Wide-field contact fundus photograph of an infant. 1240 by 1240 pixels — 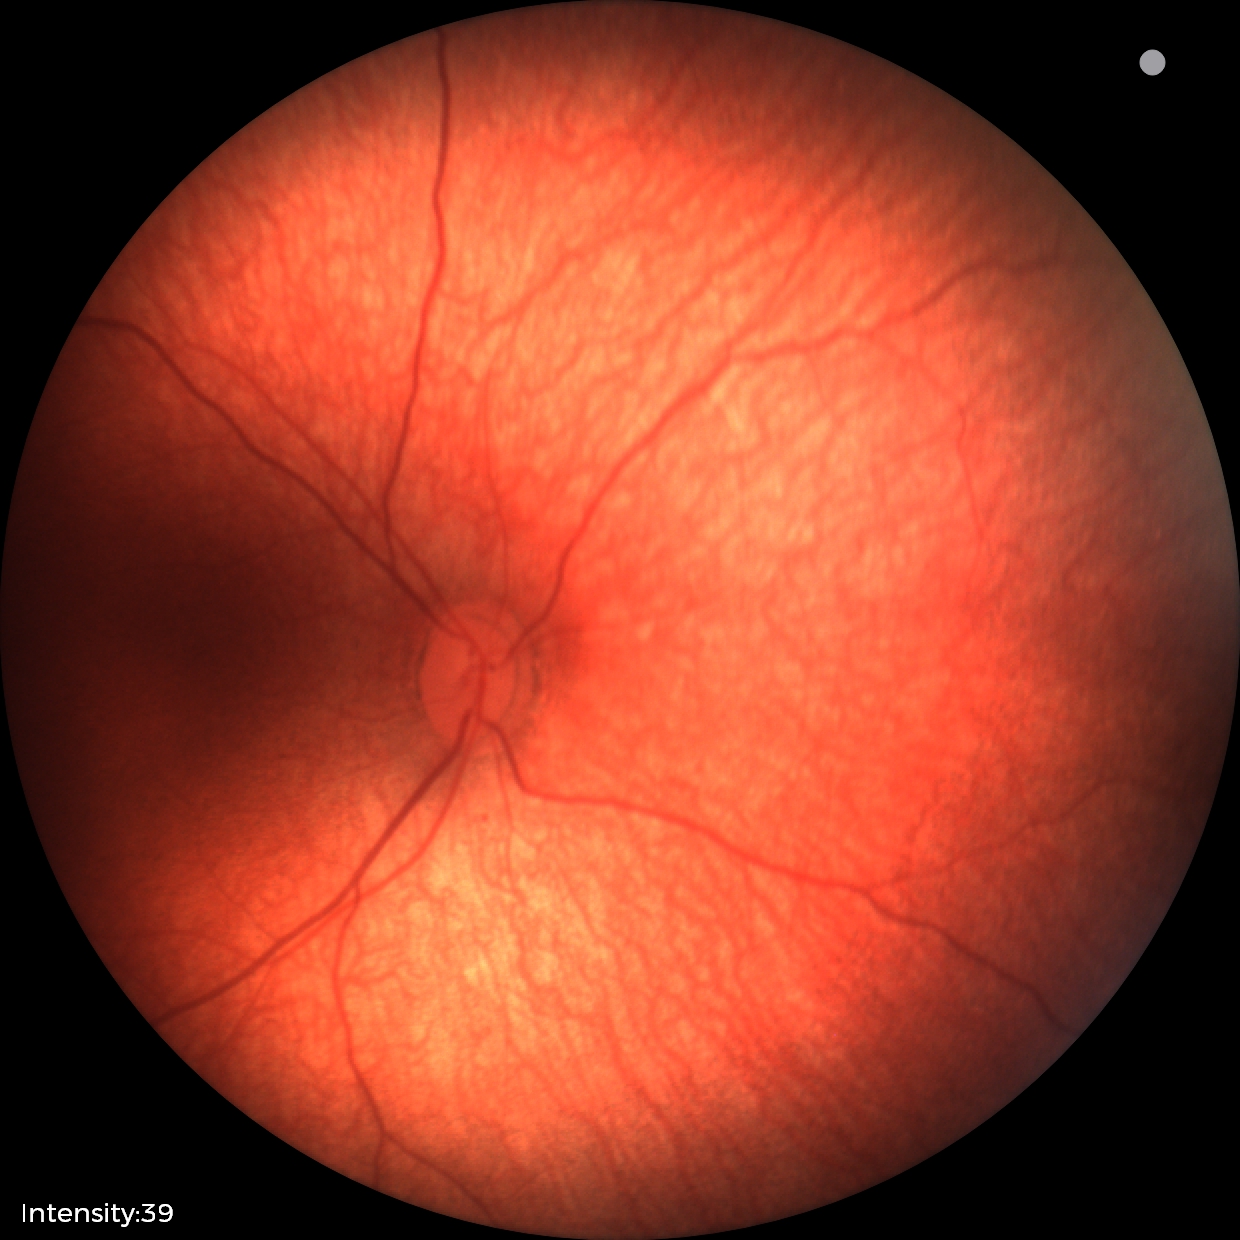
Examination with physiological retinal findings.